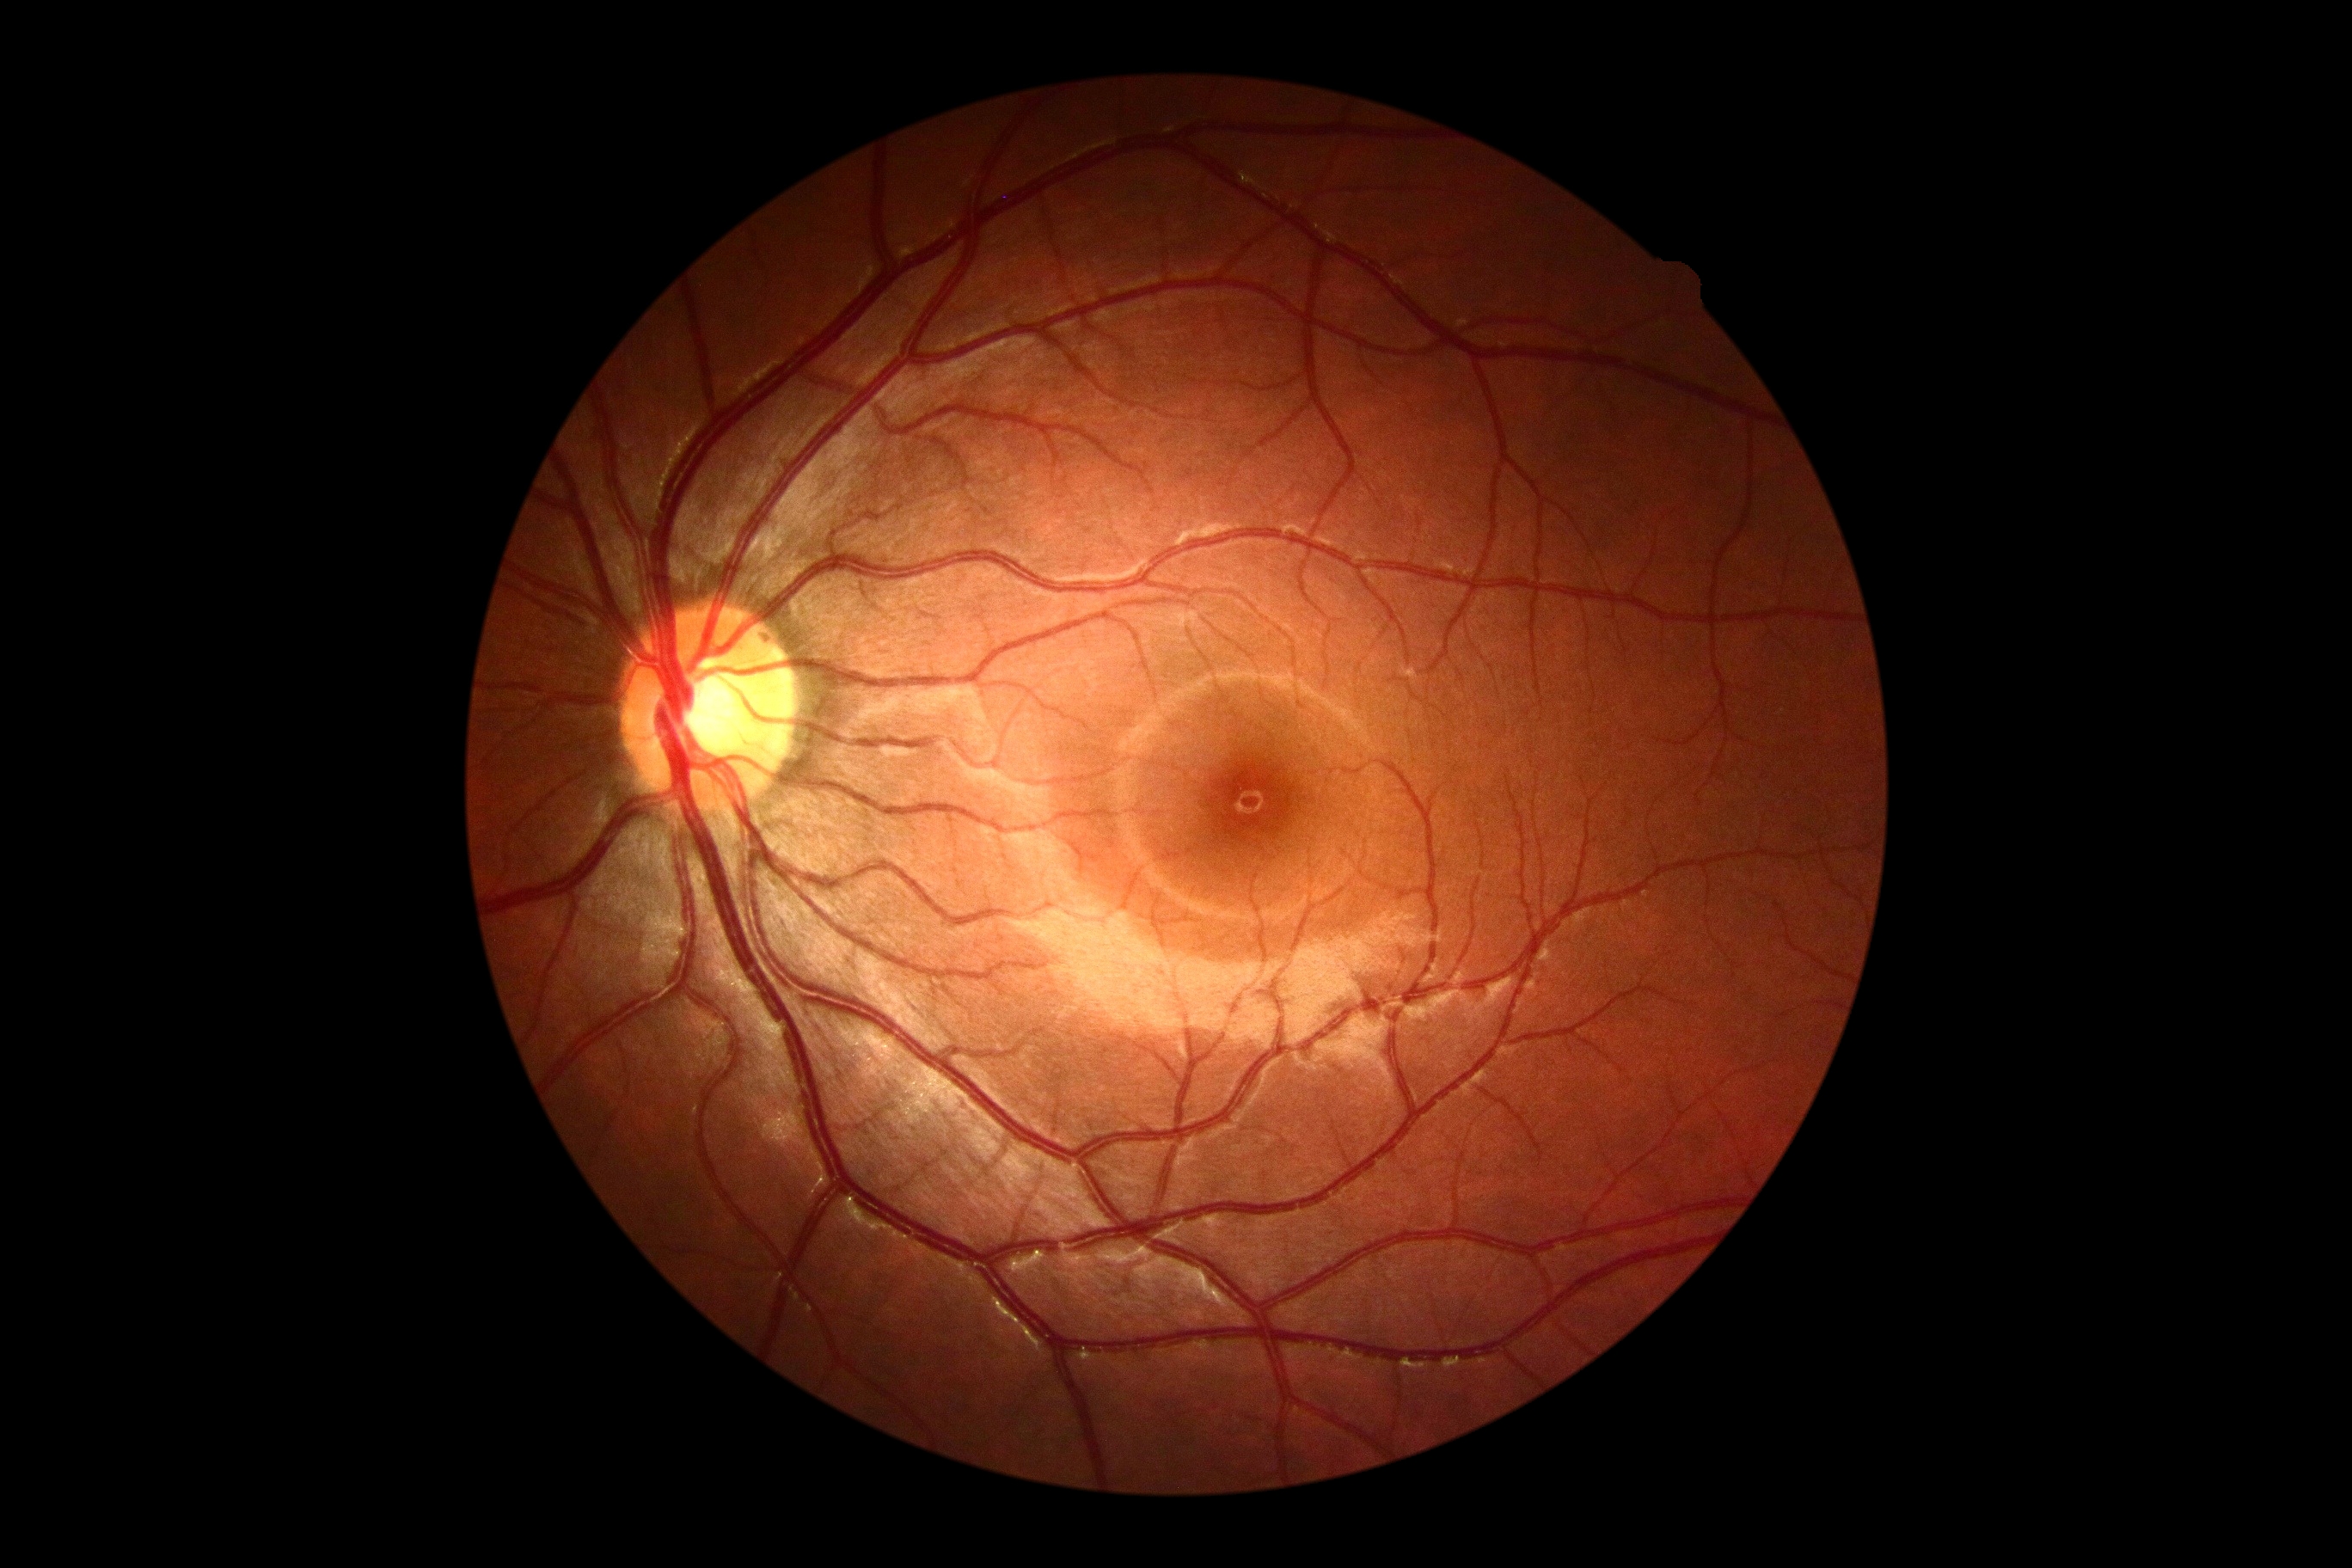 dr_grade: grade 0 (no apparent retinopathy) — no visible signs of diabetic retinopathy